Color fundus photograph · 412 x 310 pixels
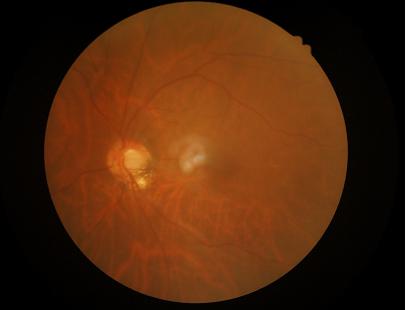
overall_quality: inadequate for clinical interpretation
clarity: optic disc, vessels, and background in focus
illumination: inadequate, with uneven exposure or color distortion
contrast: low, vessels and details hard to distinguish